Pediatric retinal photograph (wide-field): 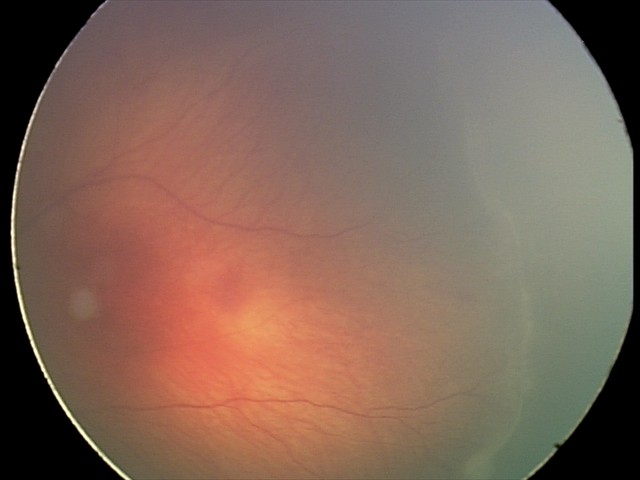

Screening diagnosis: retinopathy of prematurity stage 2; no plus disease.